Image size 2352x1568. Retinal fundus photograph. 45-degree field of view
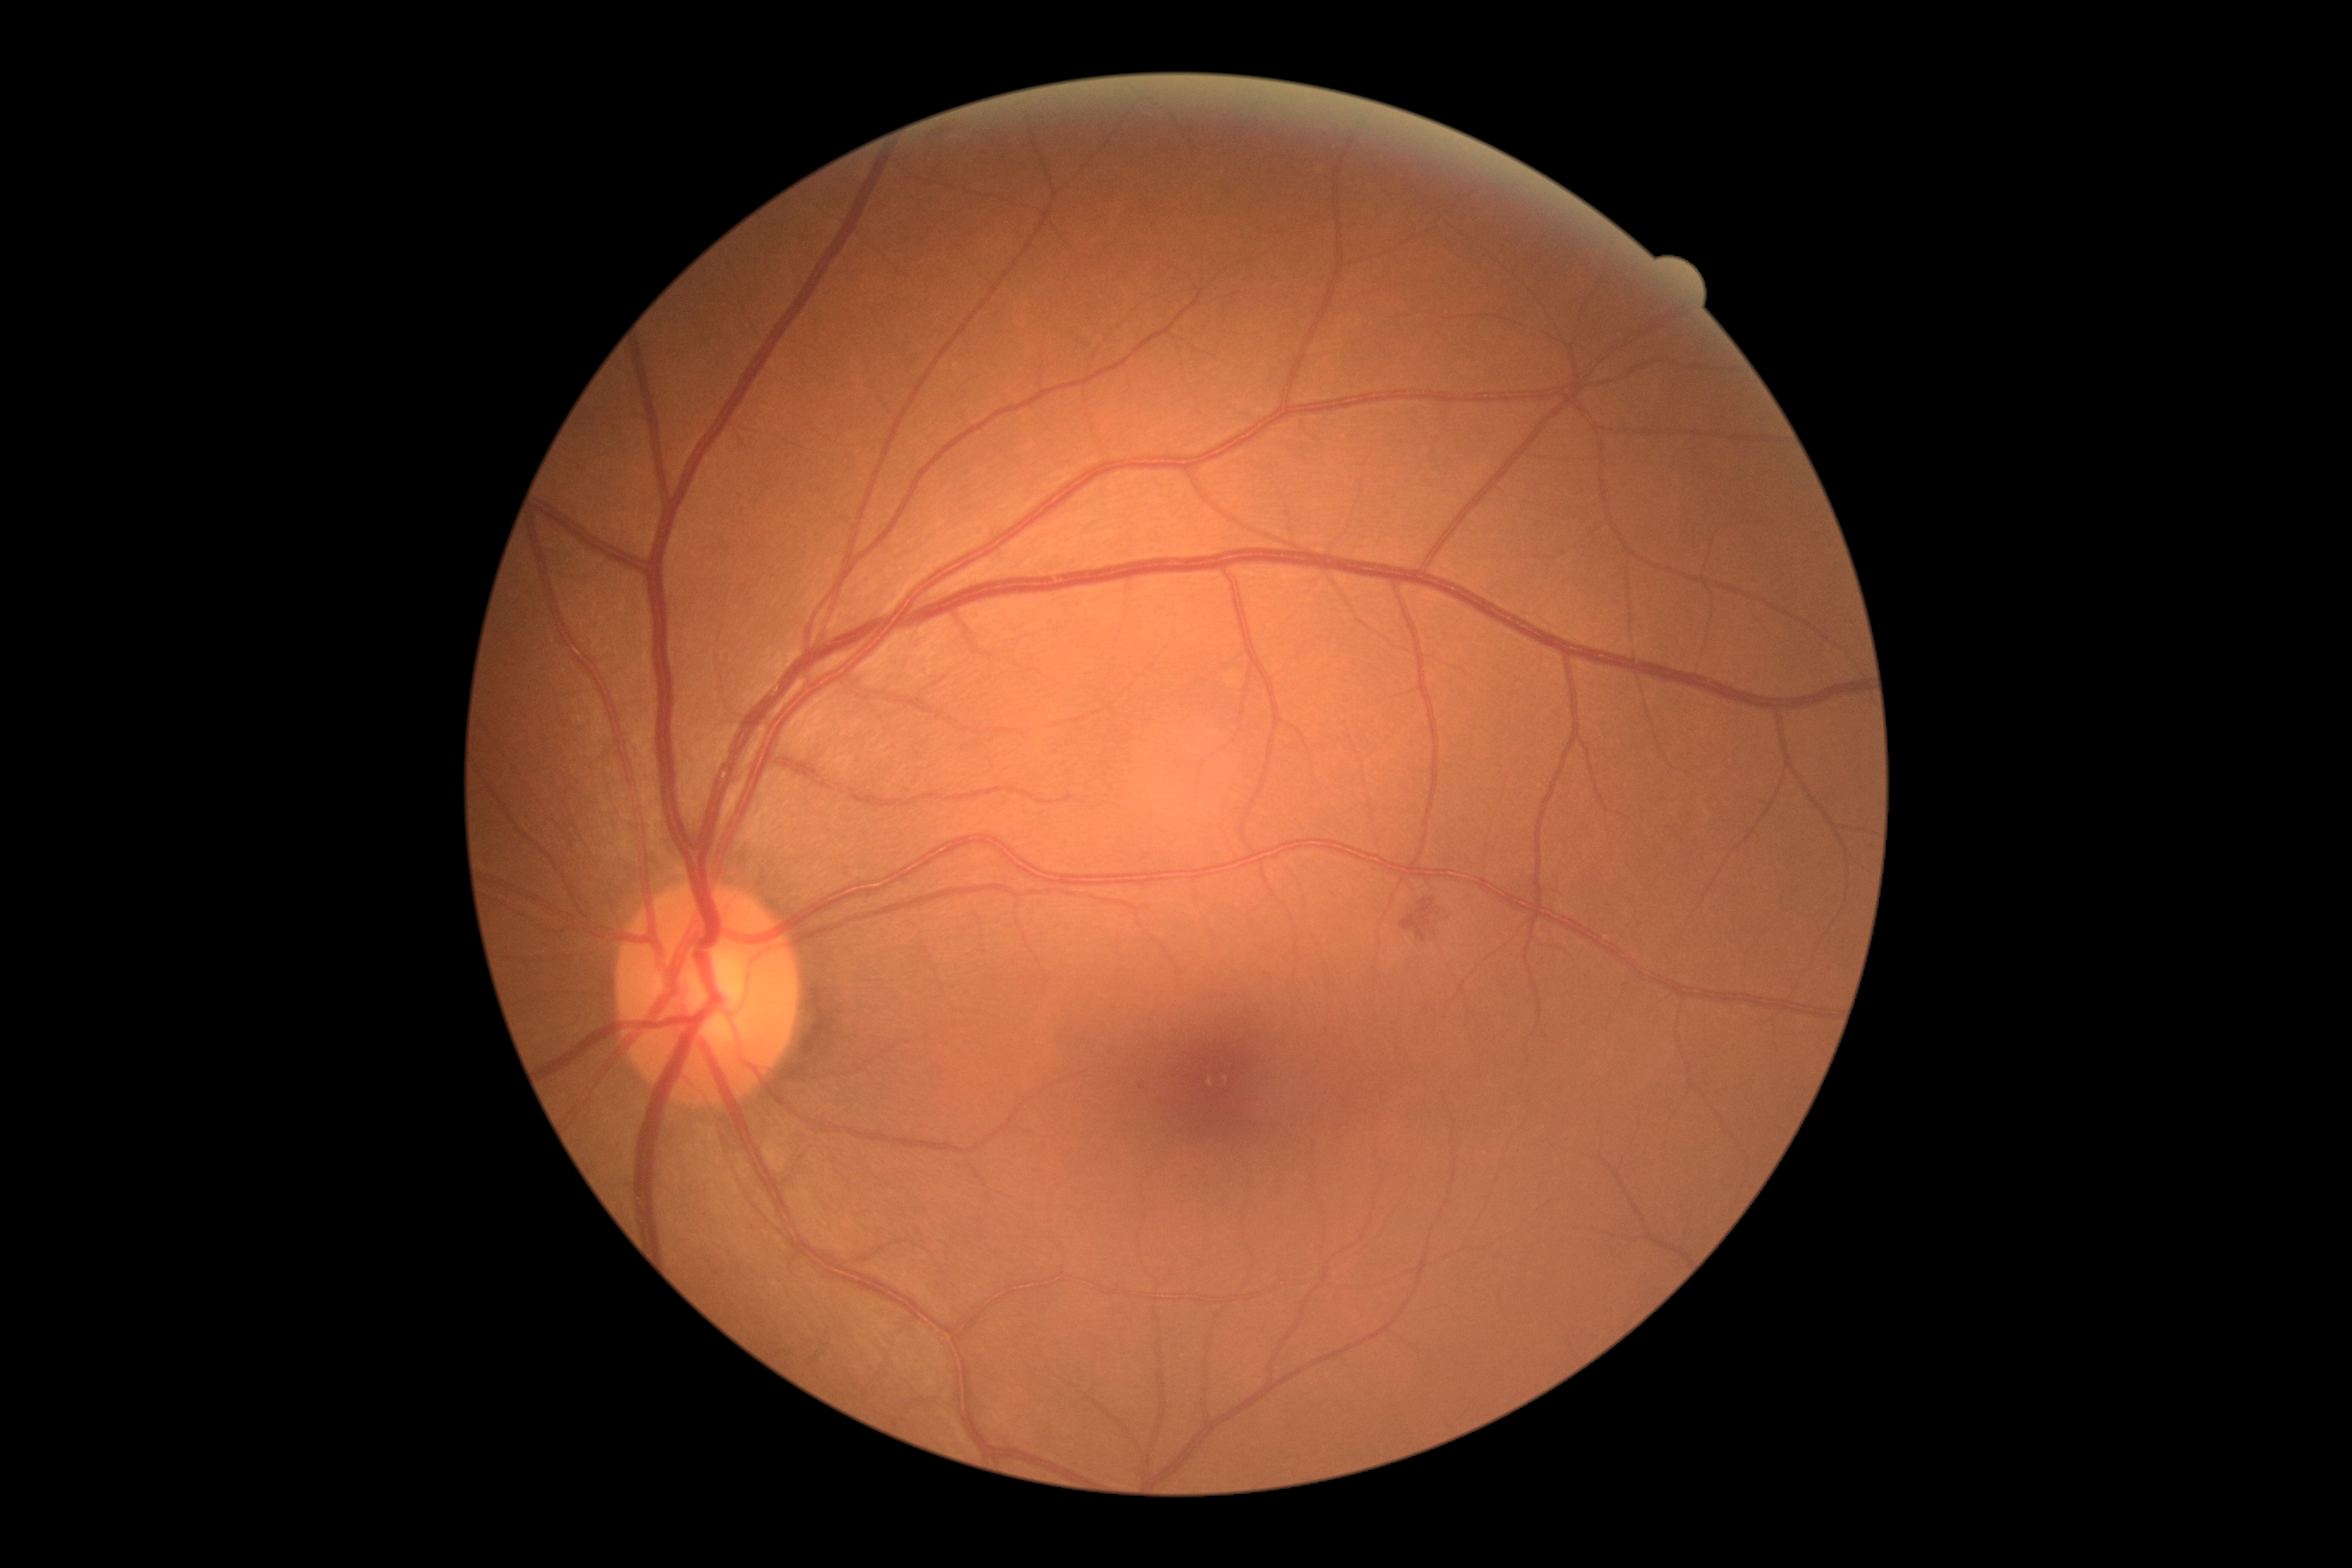
DR is grade 2 (moderate NPDR) — more than just microaneurysms but less than severe NPDR.
No EXs identified.
No SEs identified.
Additional small MAs near <pt>1142,1088</pt>.
HEs located at 1400,898,1436,941.